Fundus photo
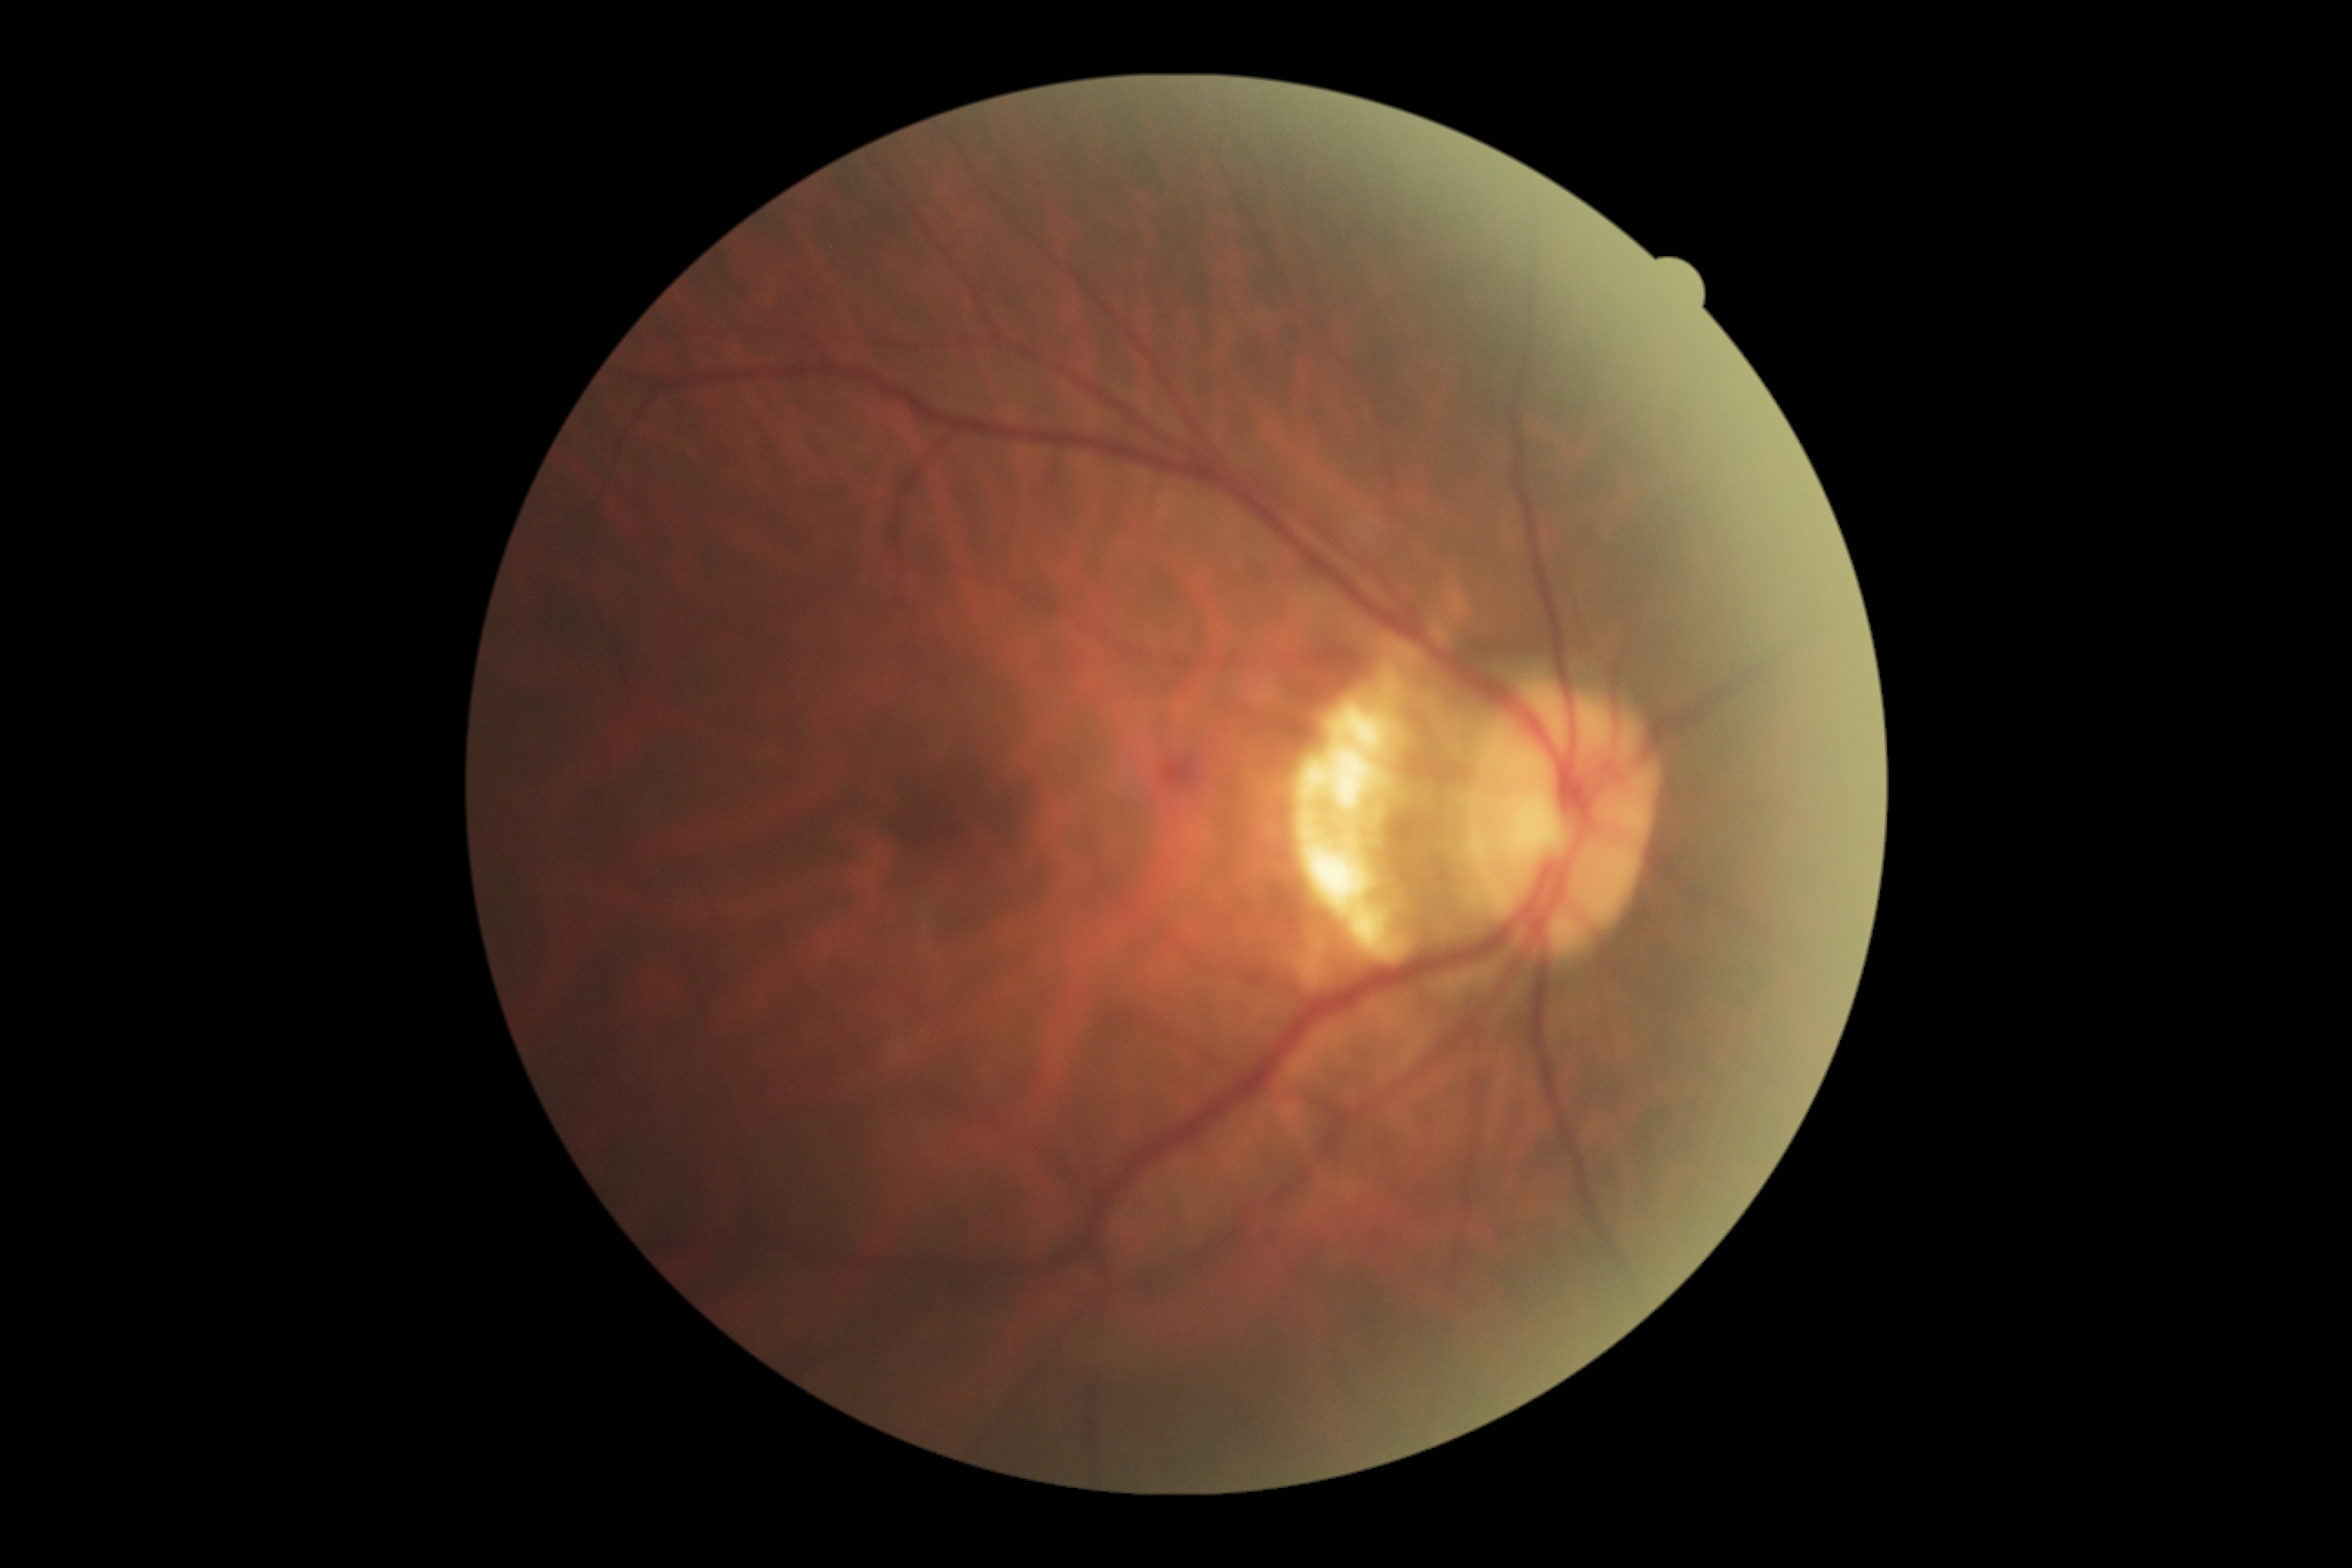 DR class: non-proliferative diabetic retinopathy.
DR stage: 2.